Diabetic retinopathy graded by the modified Davis classification — 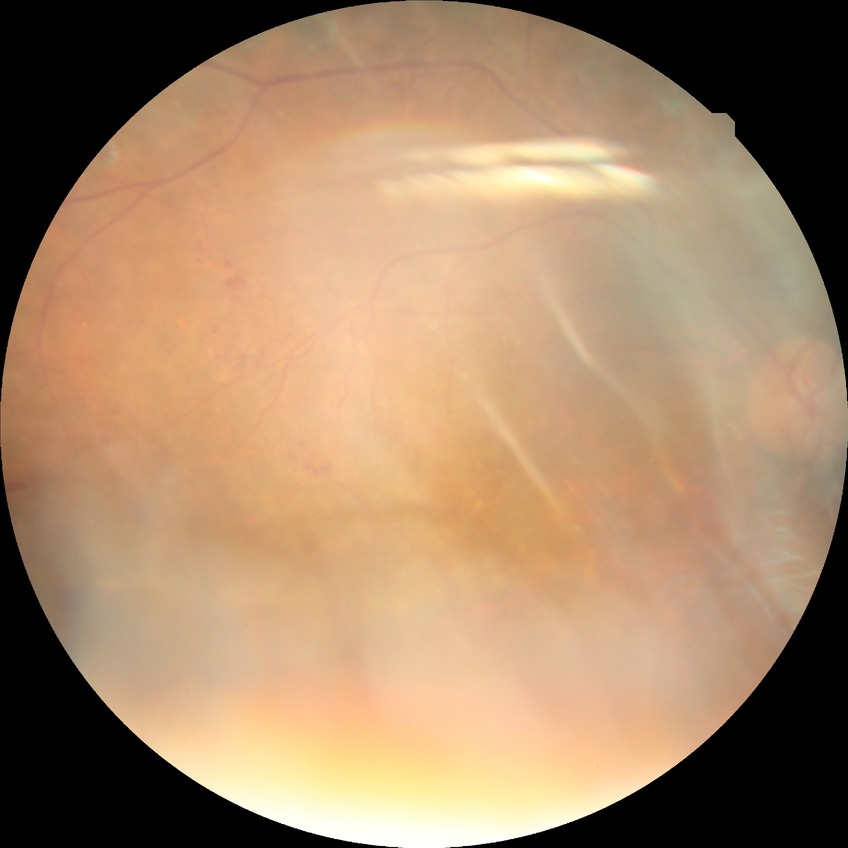
Annotations:
– diabetic retinopathy (DR) — proliferative diabetic retinopathy (PDR)